Optic disc photograph.
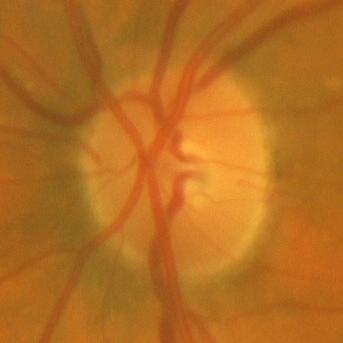 The image shows no glaucomatous findings.